Posterior pole photograph · acquired with a NIDEK AFC-230 · 45° FOV: 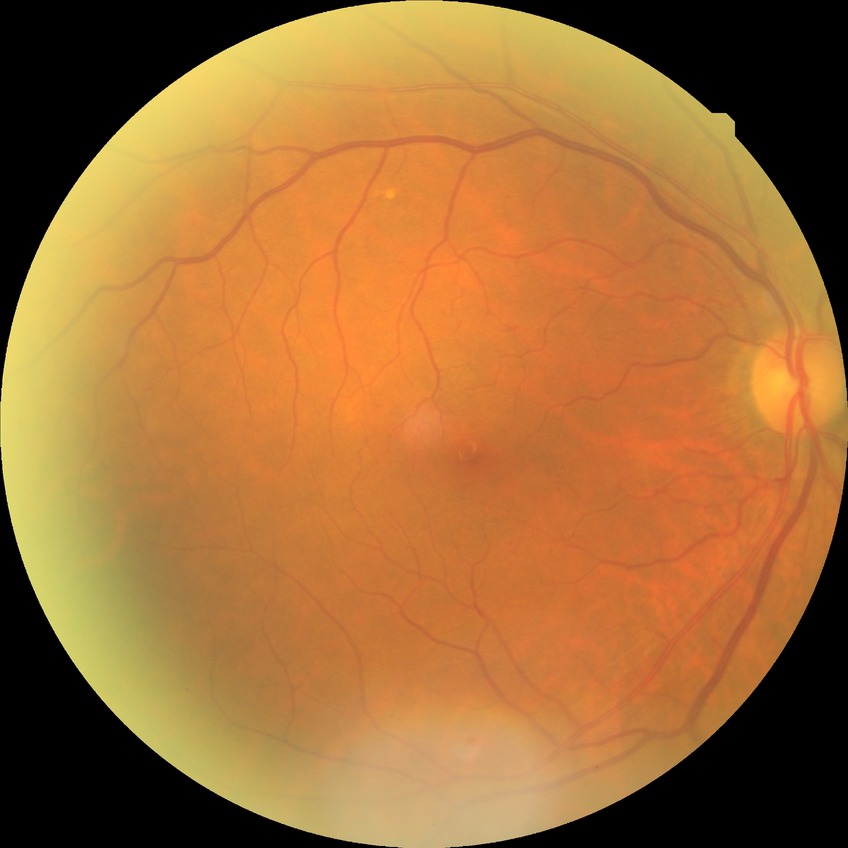

Davis grade: NDR; DR impression: negative for DR.